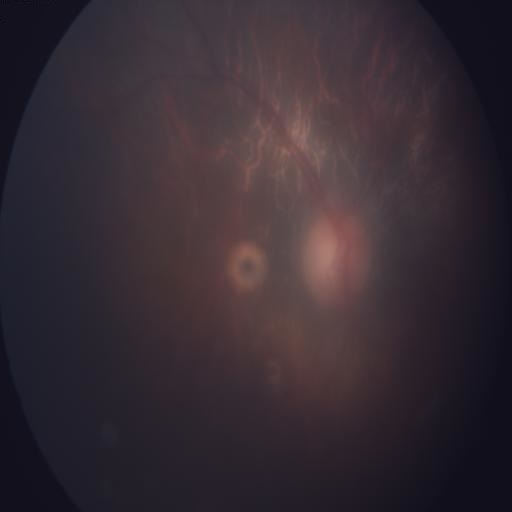 Findings (2):
- optic disc edema (ODE)
- media haze (MH)